640x480px. Pediatric wide-field fundus photograph
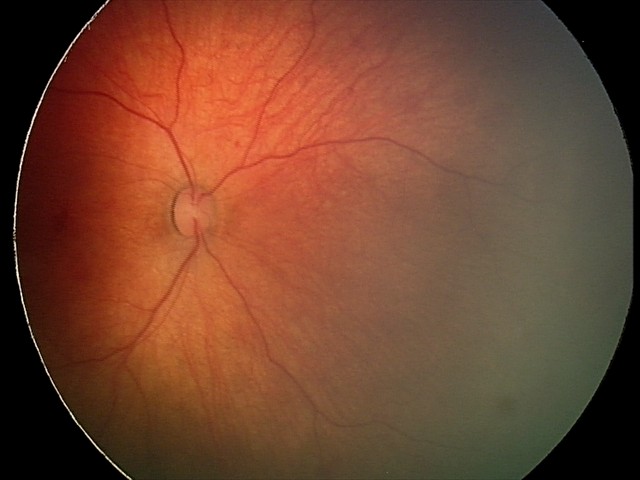

Impression: retinal hemorrhages